45° FOV. 2048x1536px. Retinal fundus photograph — 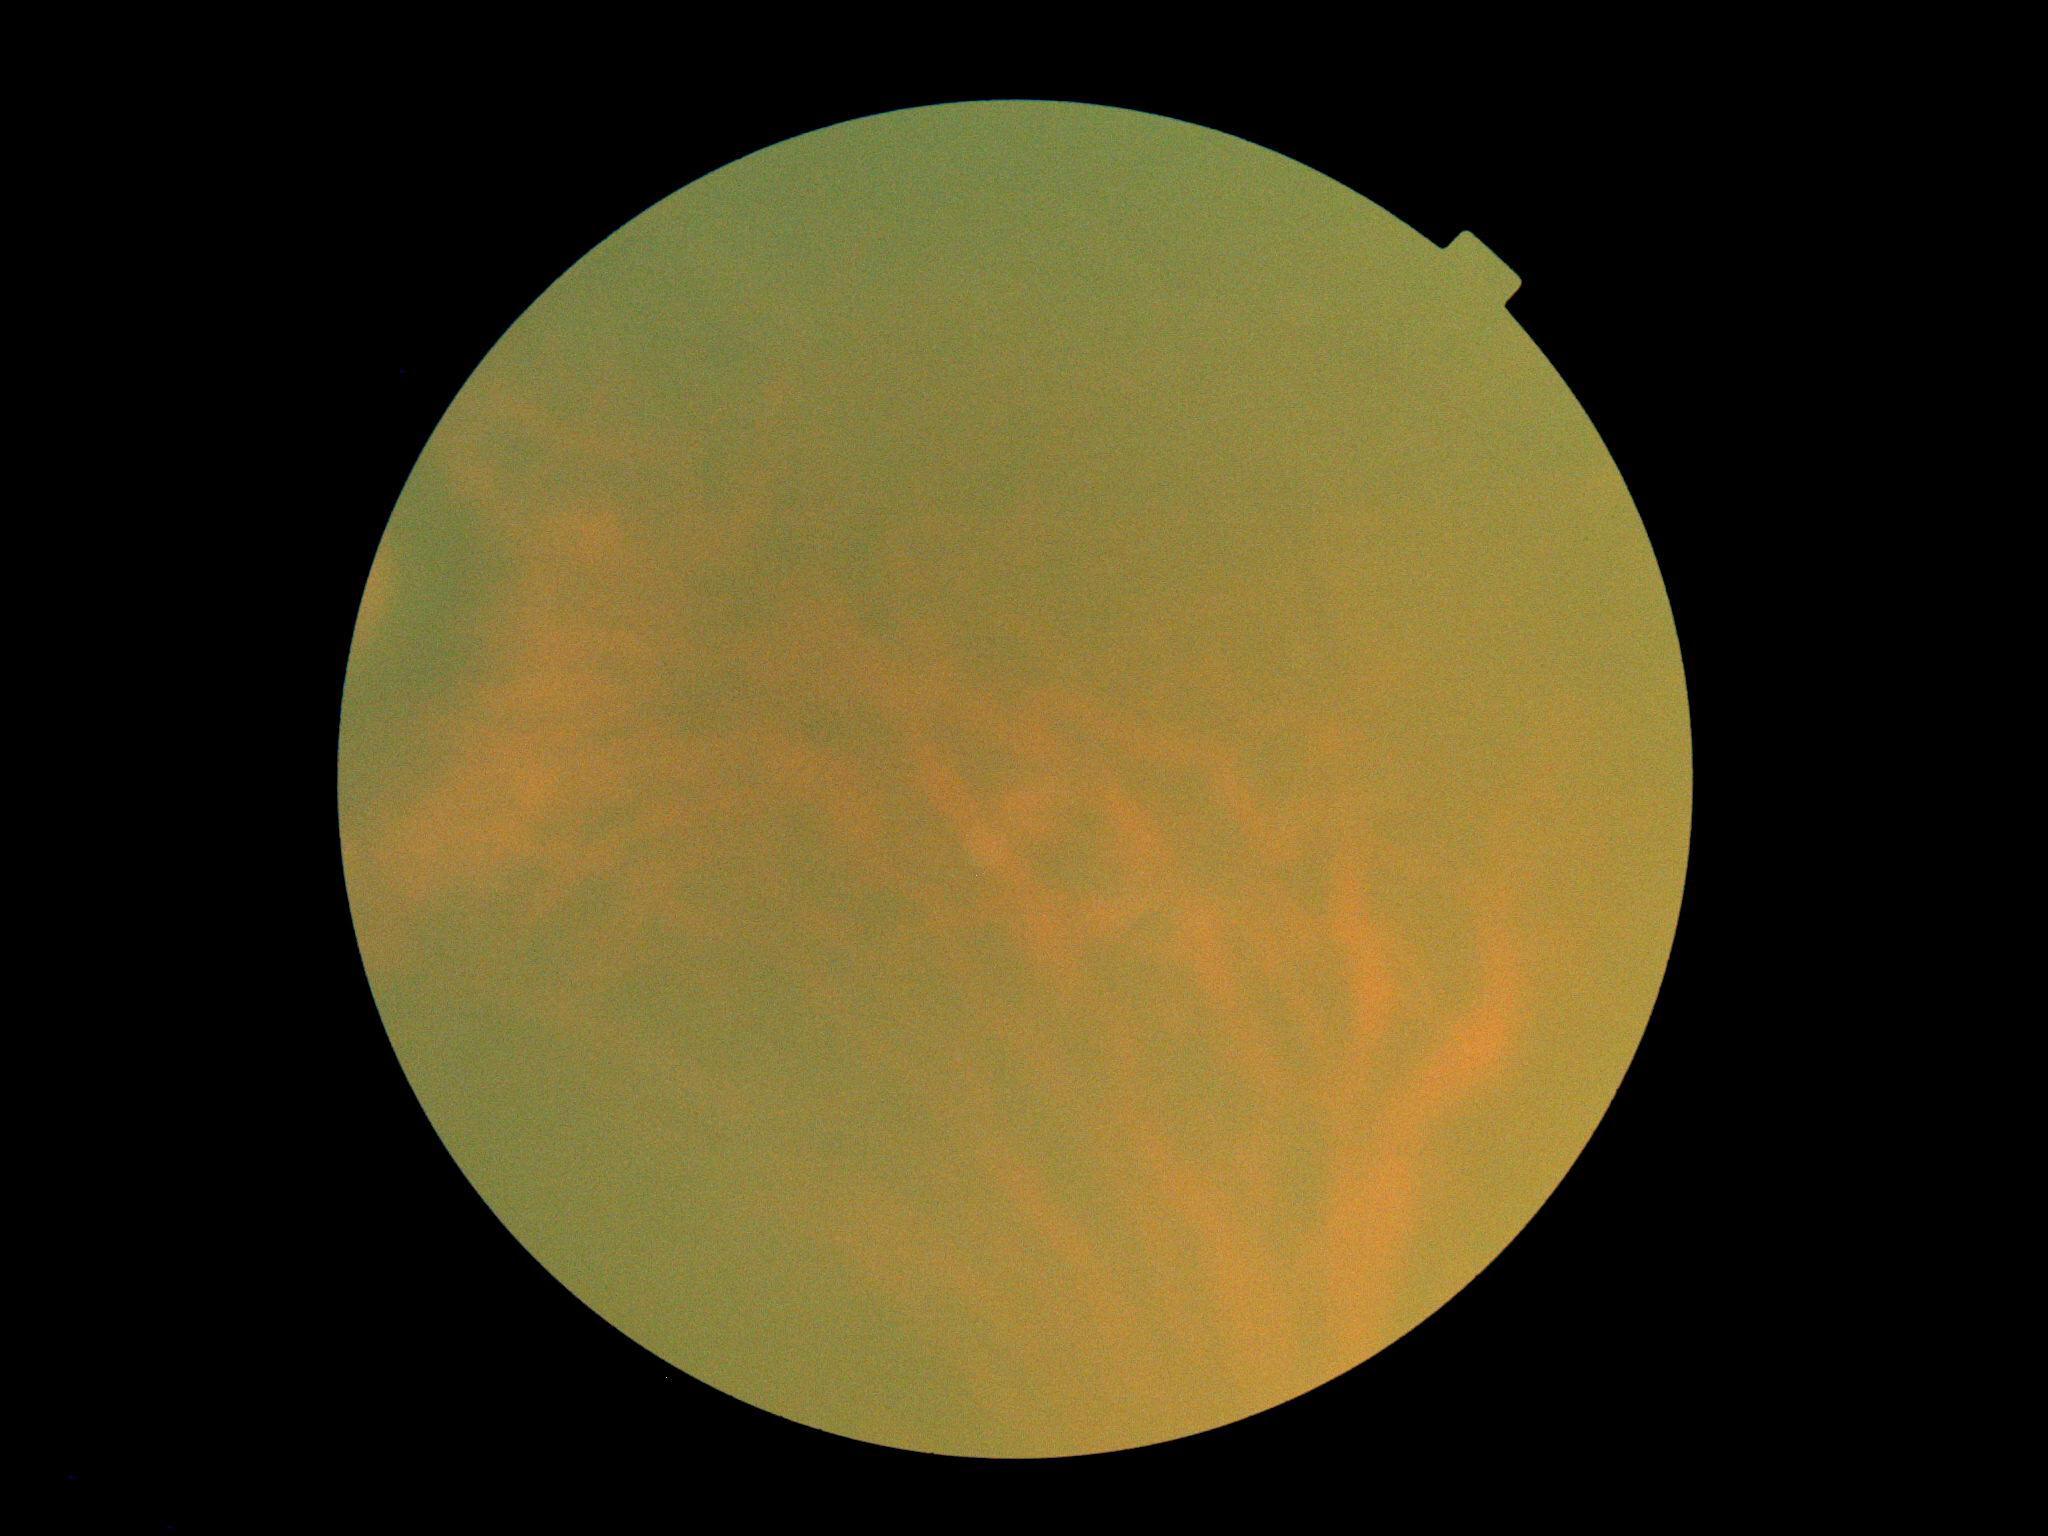 image quality = too poor for DR grading | DR stage = ungradable due to poor image quality.